FOV: 45 degrees:
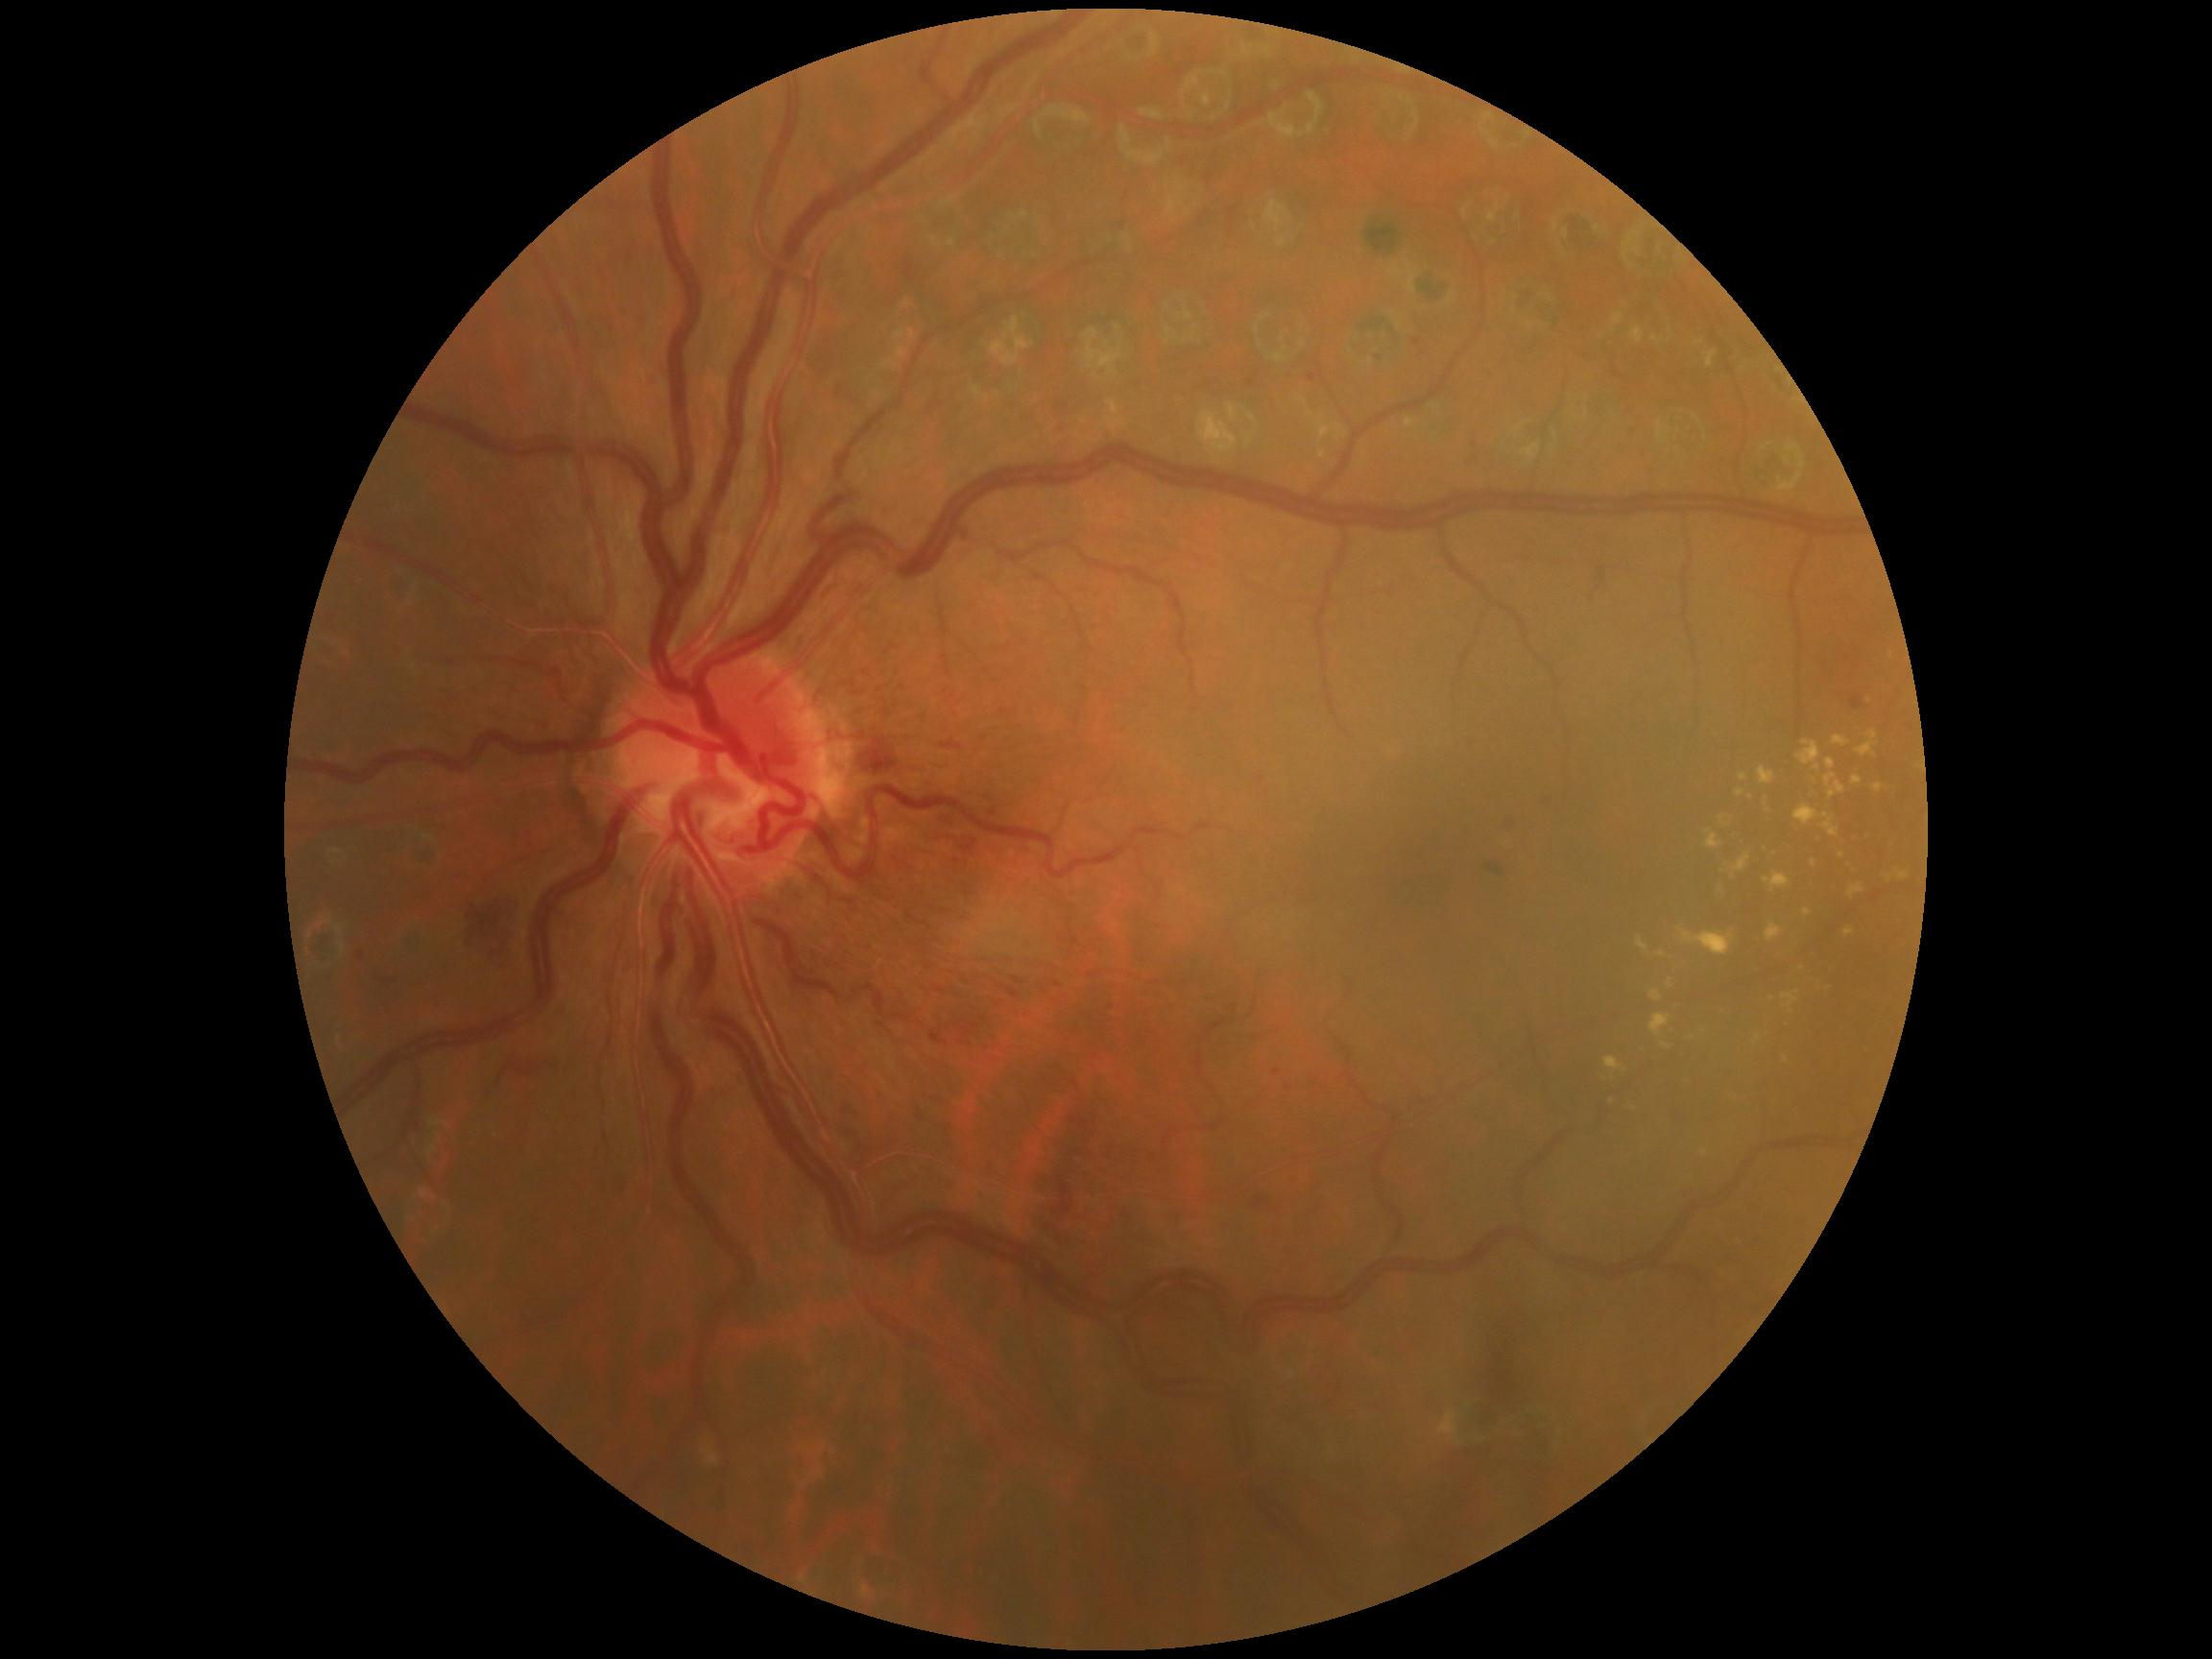 Retinopathy grade: 2/4 — more than just microaneurysms but less than severe NPDR.
No soft exudates identified.
Hemorrhages include lesions at (985,805,999,818); (465,895,523,974); (1531,792,1559,816); (479,1088,493,1102); (354,951,366,963); (1049,419,1073,438); (936,811,958,830); (832,379,862,409); (1061,1186,1073,1214); (980,792,995,802); (925,832,980,858).
Small hemorrhages near 1252, 384; 1288, 1089; 1075, 942.
Hard exudates include lesions at (1820,813,1839,837); (1662,1042,1674,1051); (1677,927,1736,956); (1763,873,1791,894); (1751,1035,1763,1046); (1650,990,1663,1003); (1848,884,1865,901); (1784,1056,1790,1066); (1605,1057,1627,1082); (1667,978,1674,990); (1700,1149,1710,1157); (1885,870,1911,884).
Small hard exudates near 1737, 1099; 1829, 989; 1612, 1102; 1772, 1000; 1733, 878; 1605, 1079.
No microaneurysms identified.